Acquired with a Topcon TRC-NW8, fundus photo, 50-degree field of view.
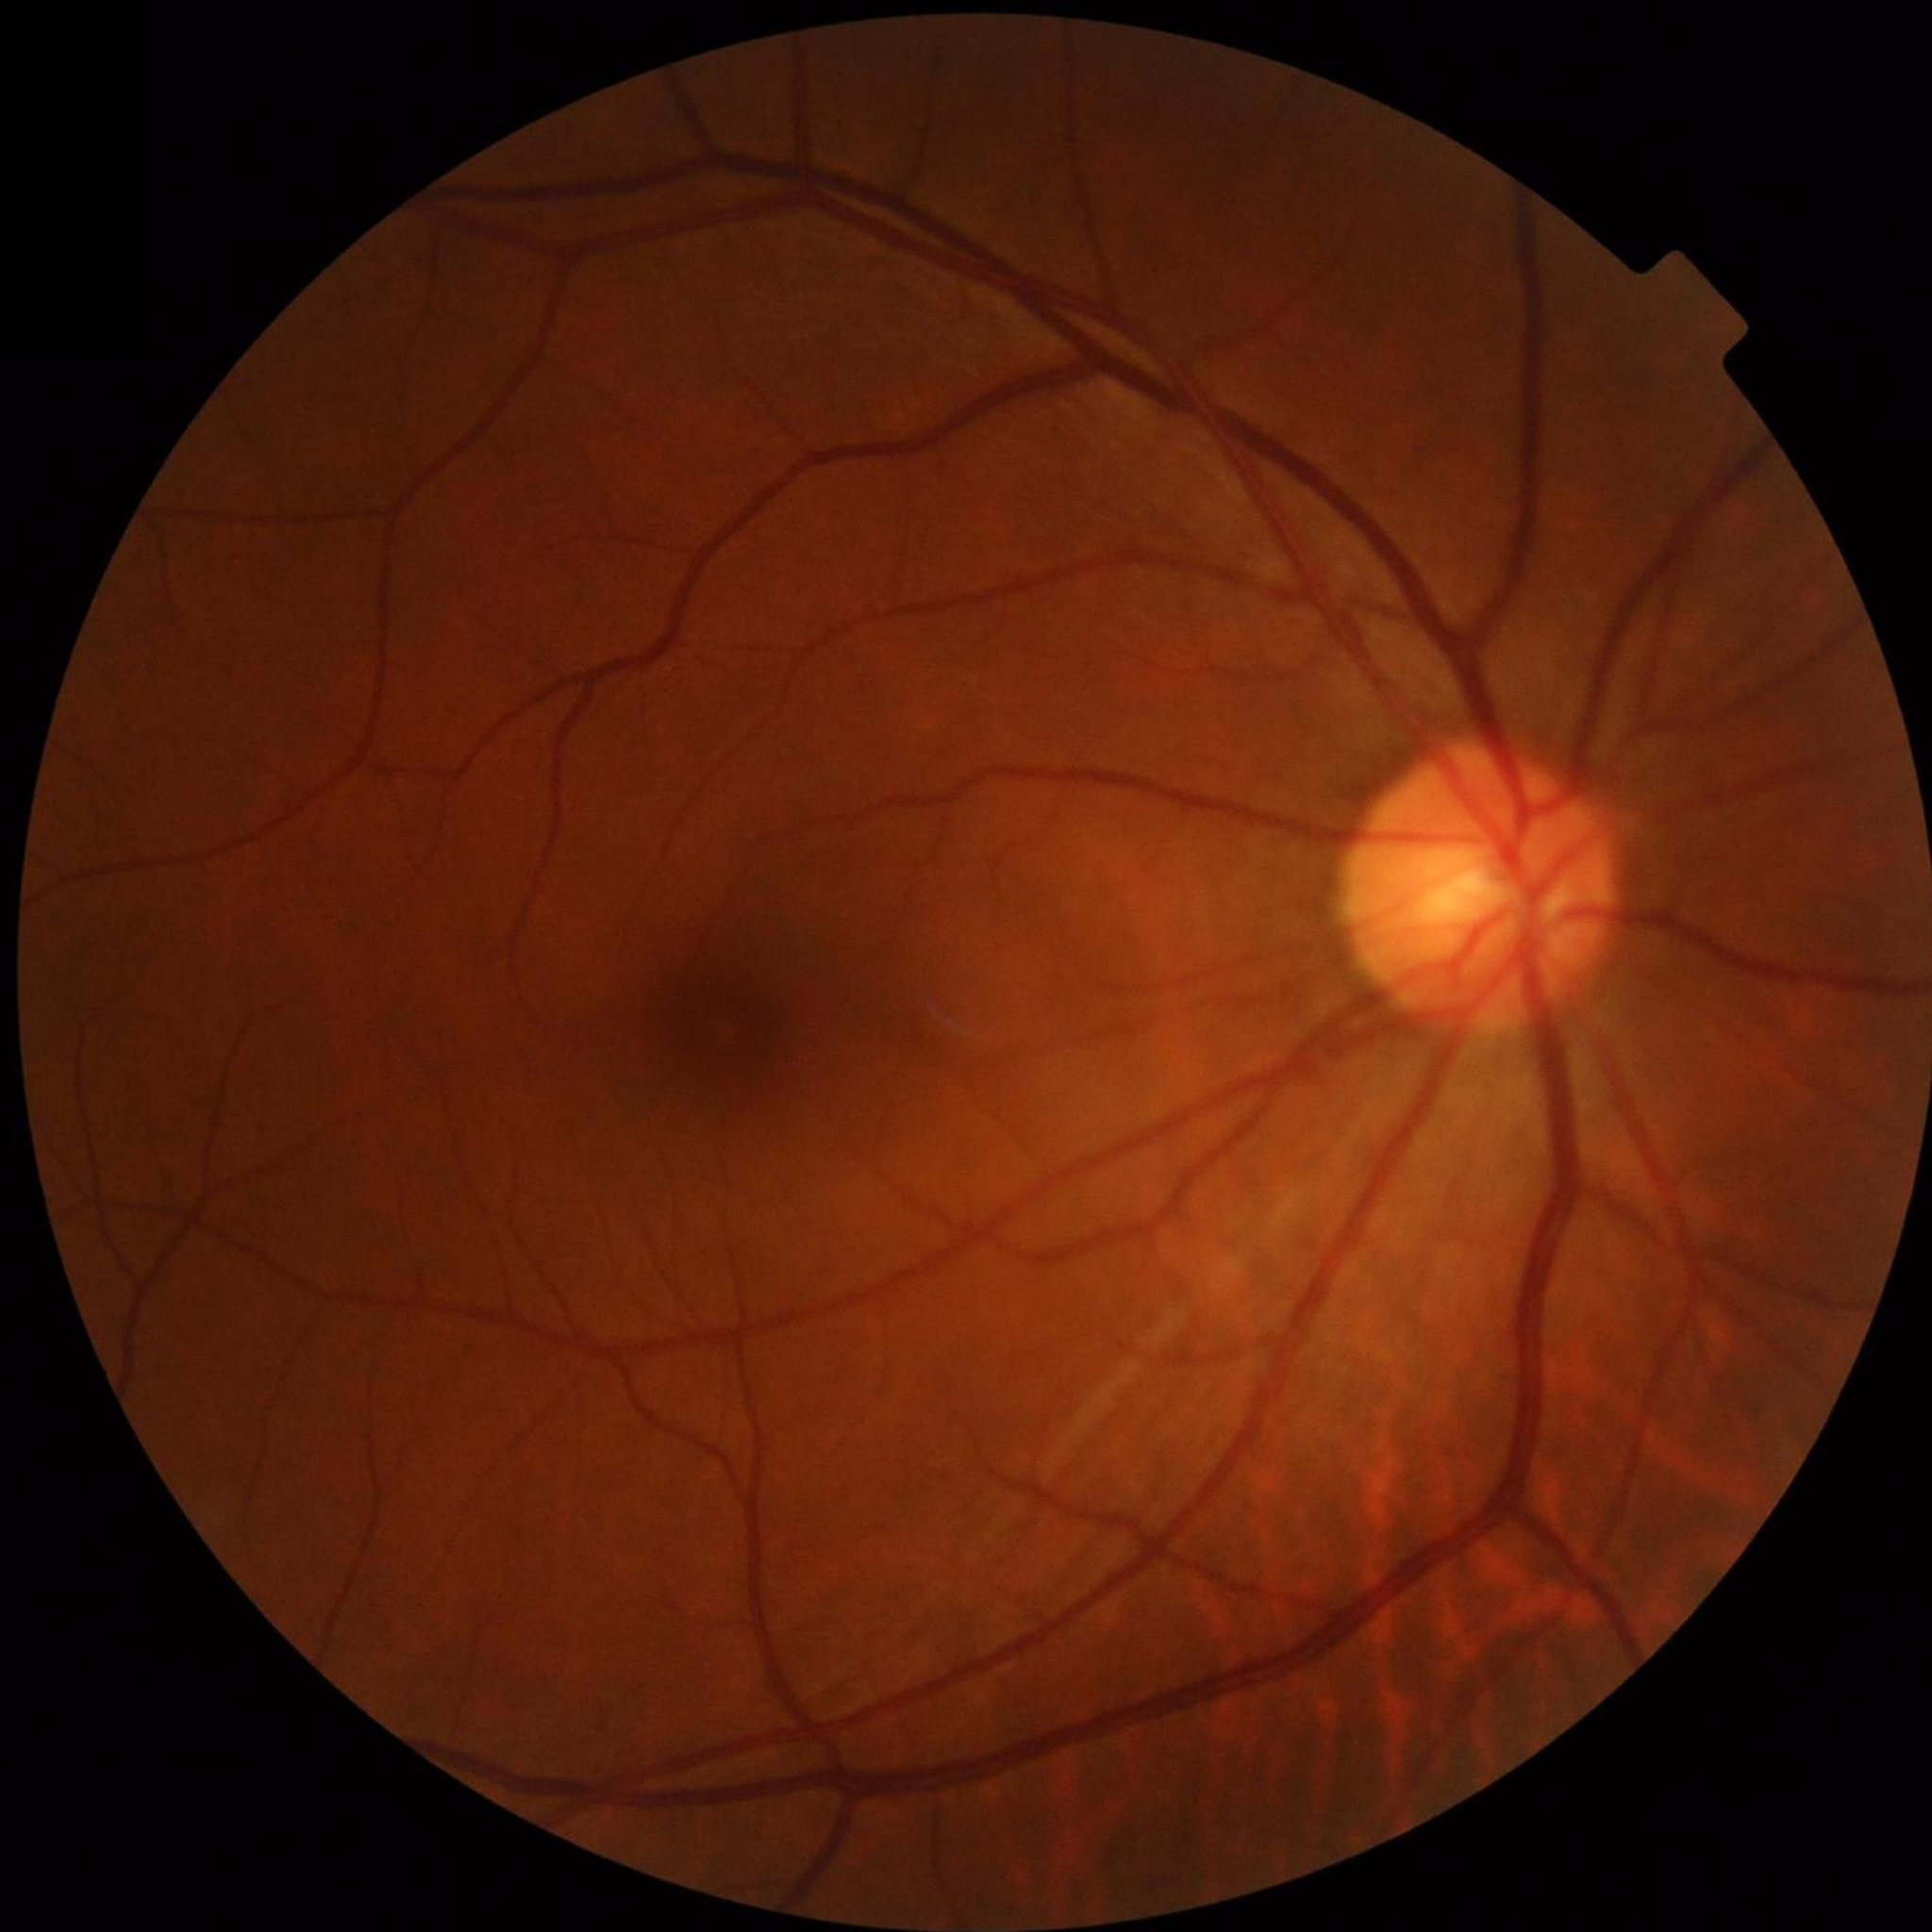 No findings of AMD, diabetic retinopathy, or glaucoma.